NIDEK AFC-230: 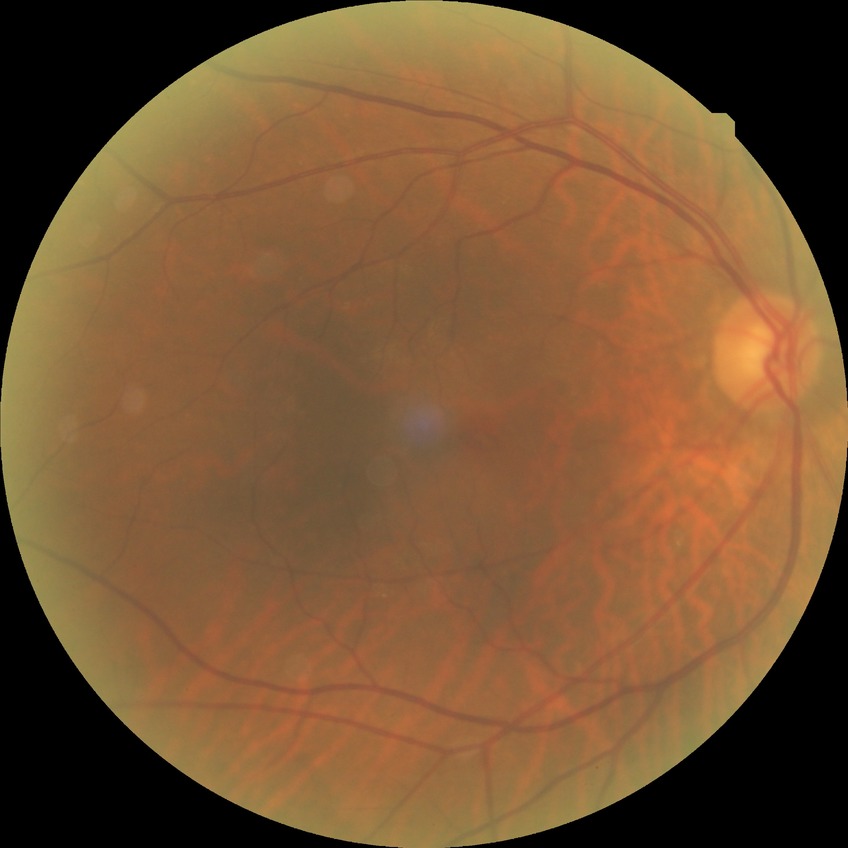 Diabetic retinopathy (DR): no diabetic retinopathy (NDR).